NIDEK AFC-230 fundus camera; 848x848; graded on the modified Davis scale: 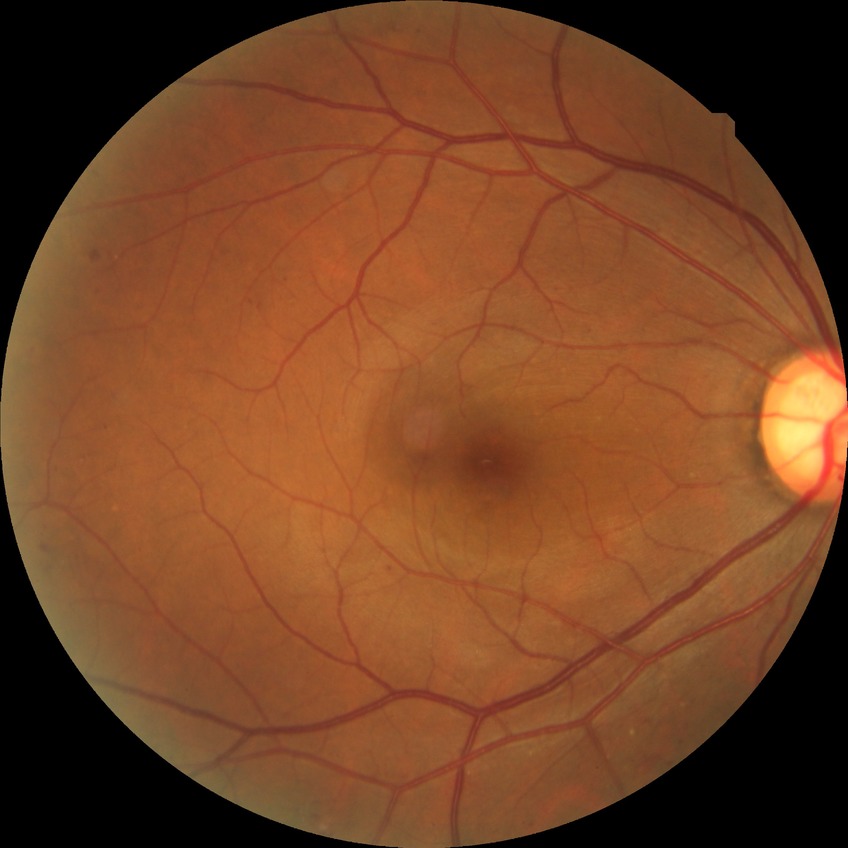
davis_grade: simple diabetic retinopathy